1659 by 2212 pixels — 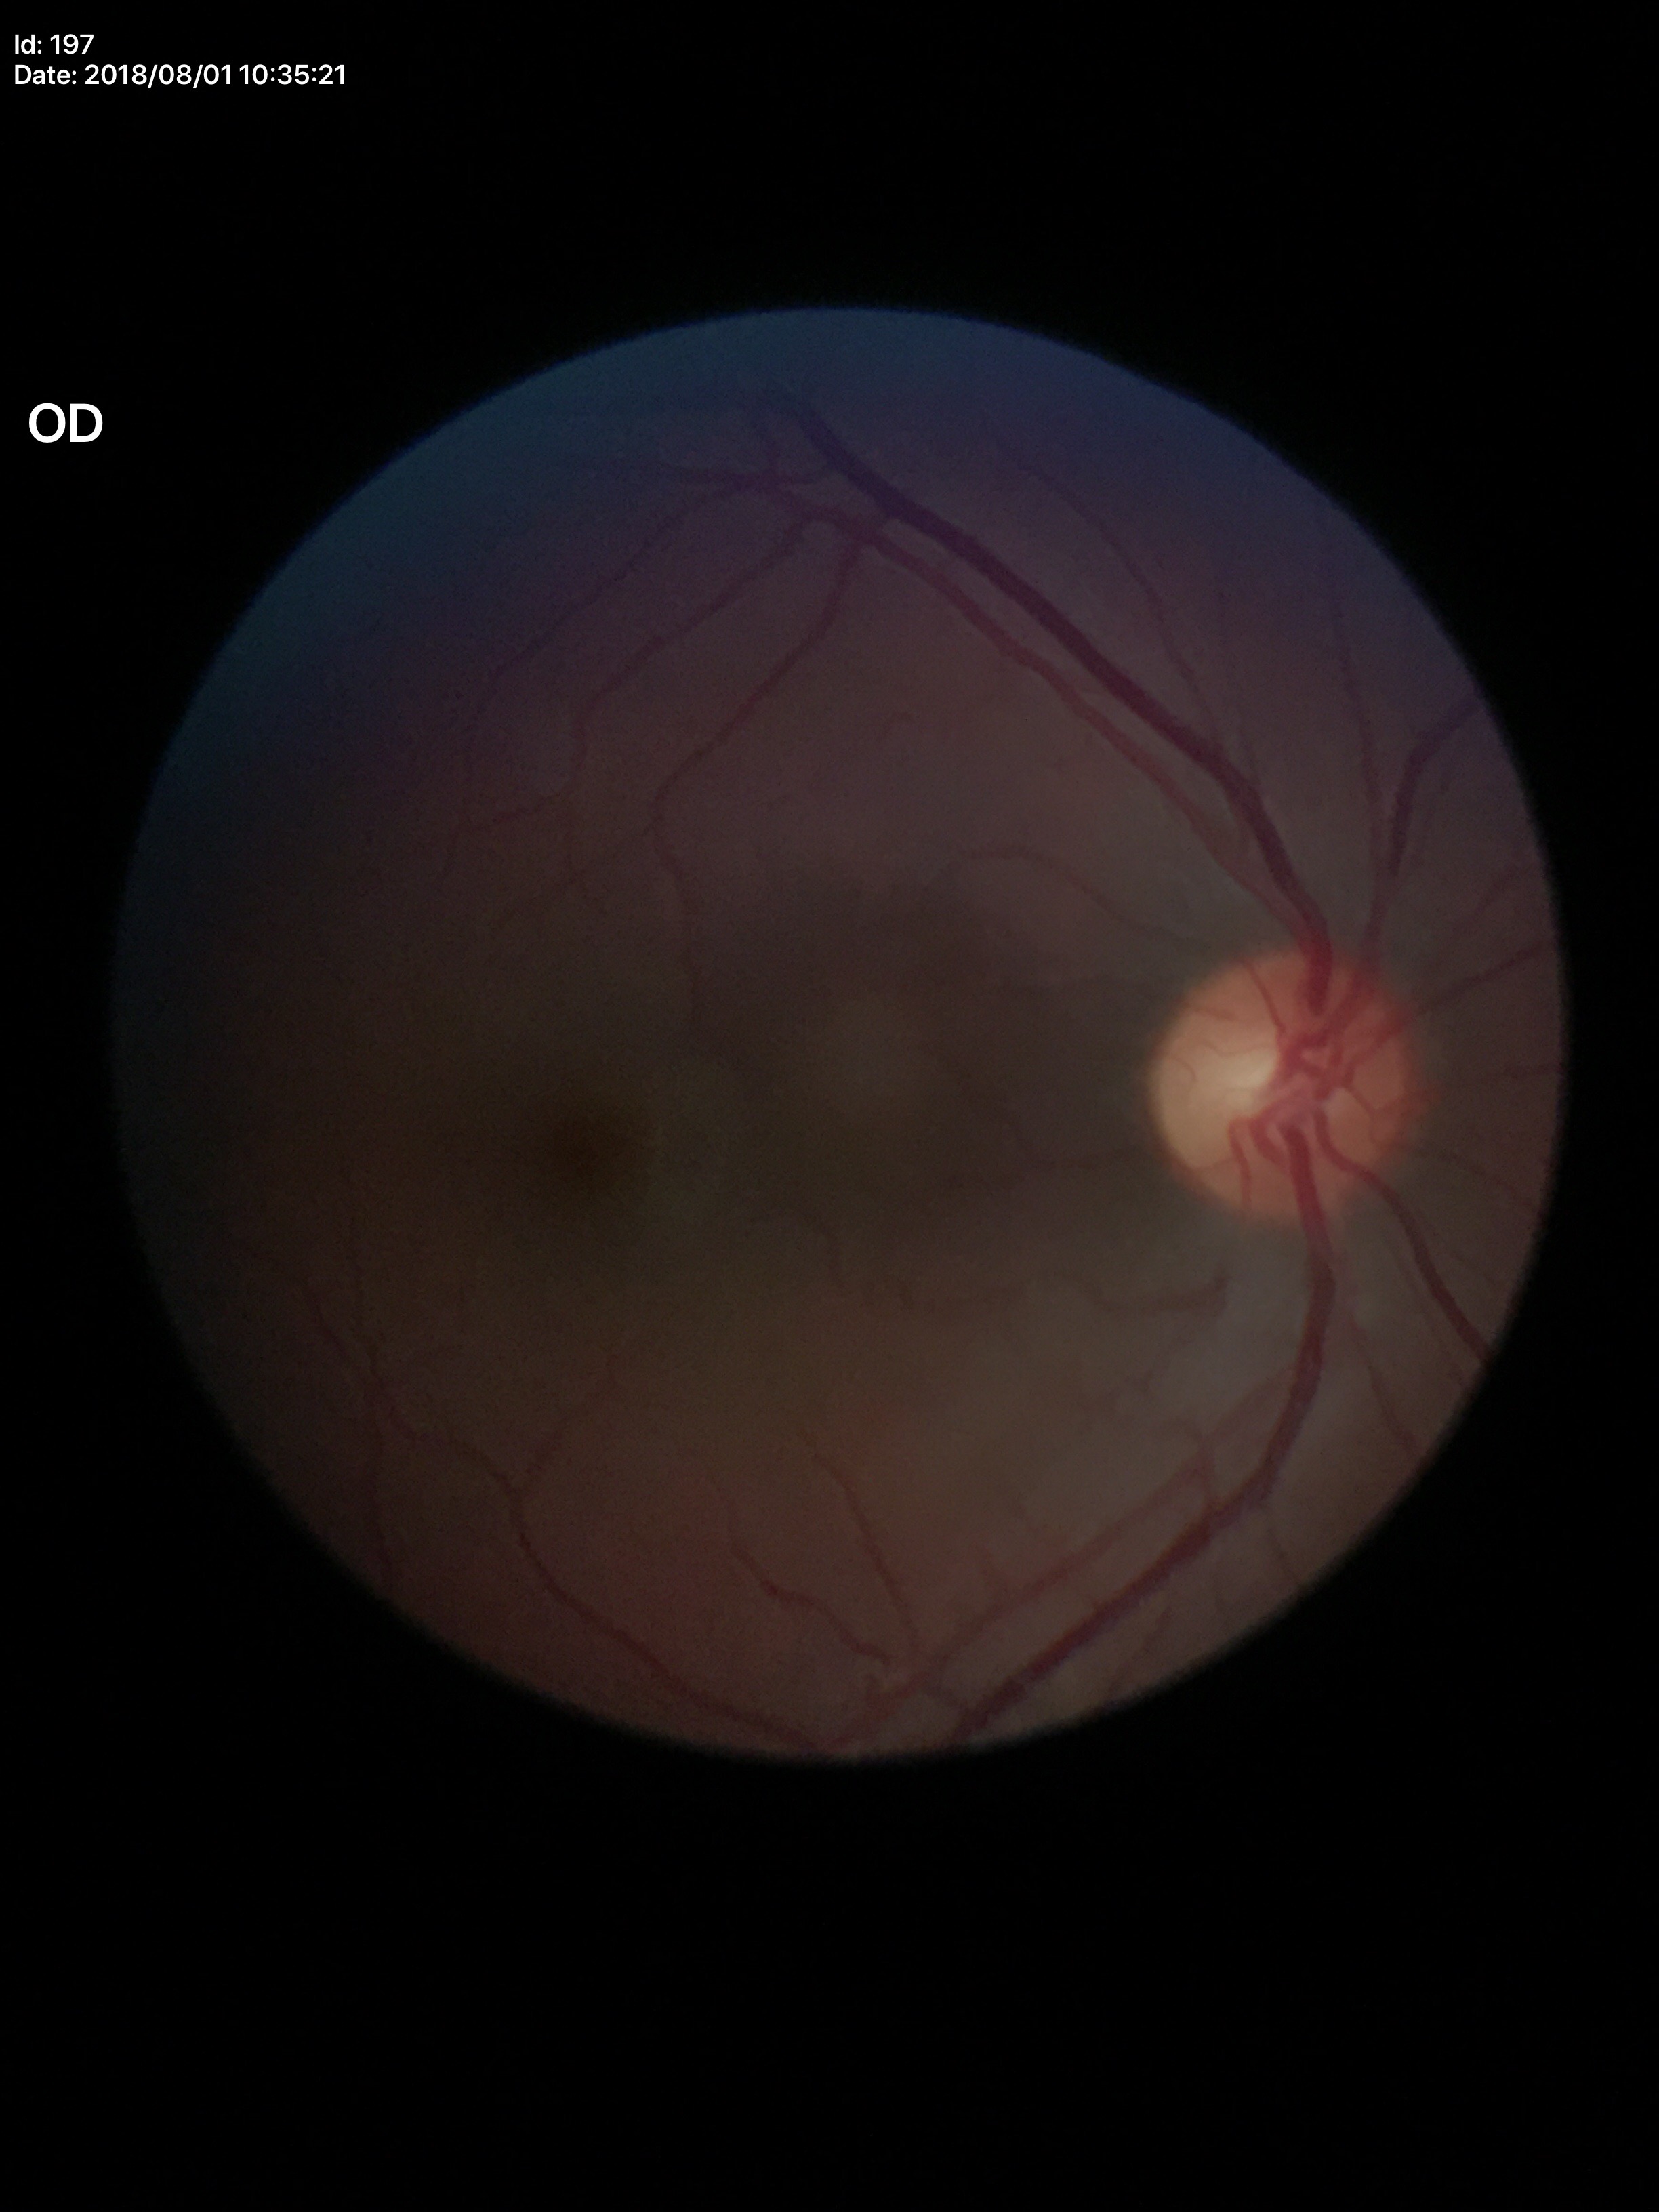

{"glaucoma_decision": "not suspect", "vcdr": "0.48"}